UWF retinal mosaic.
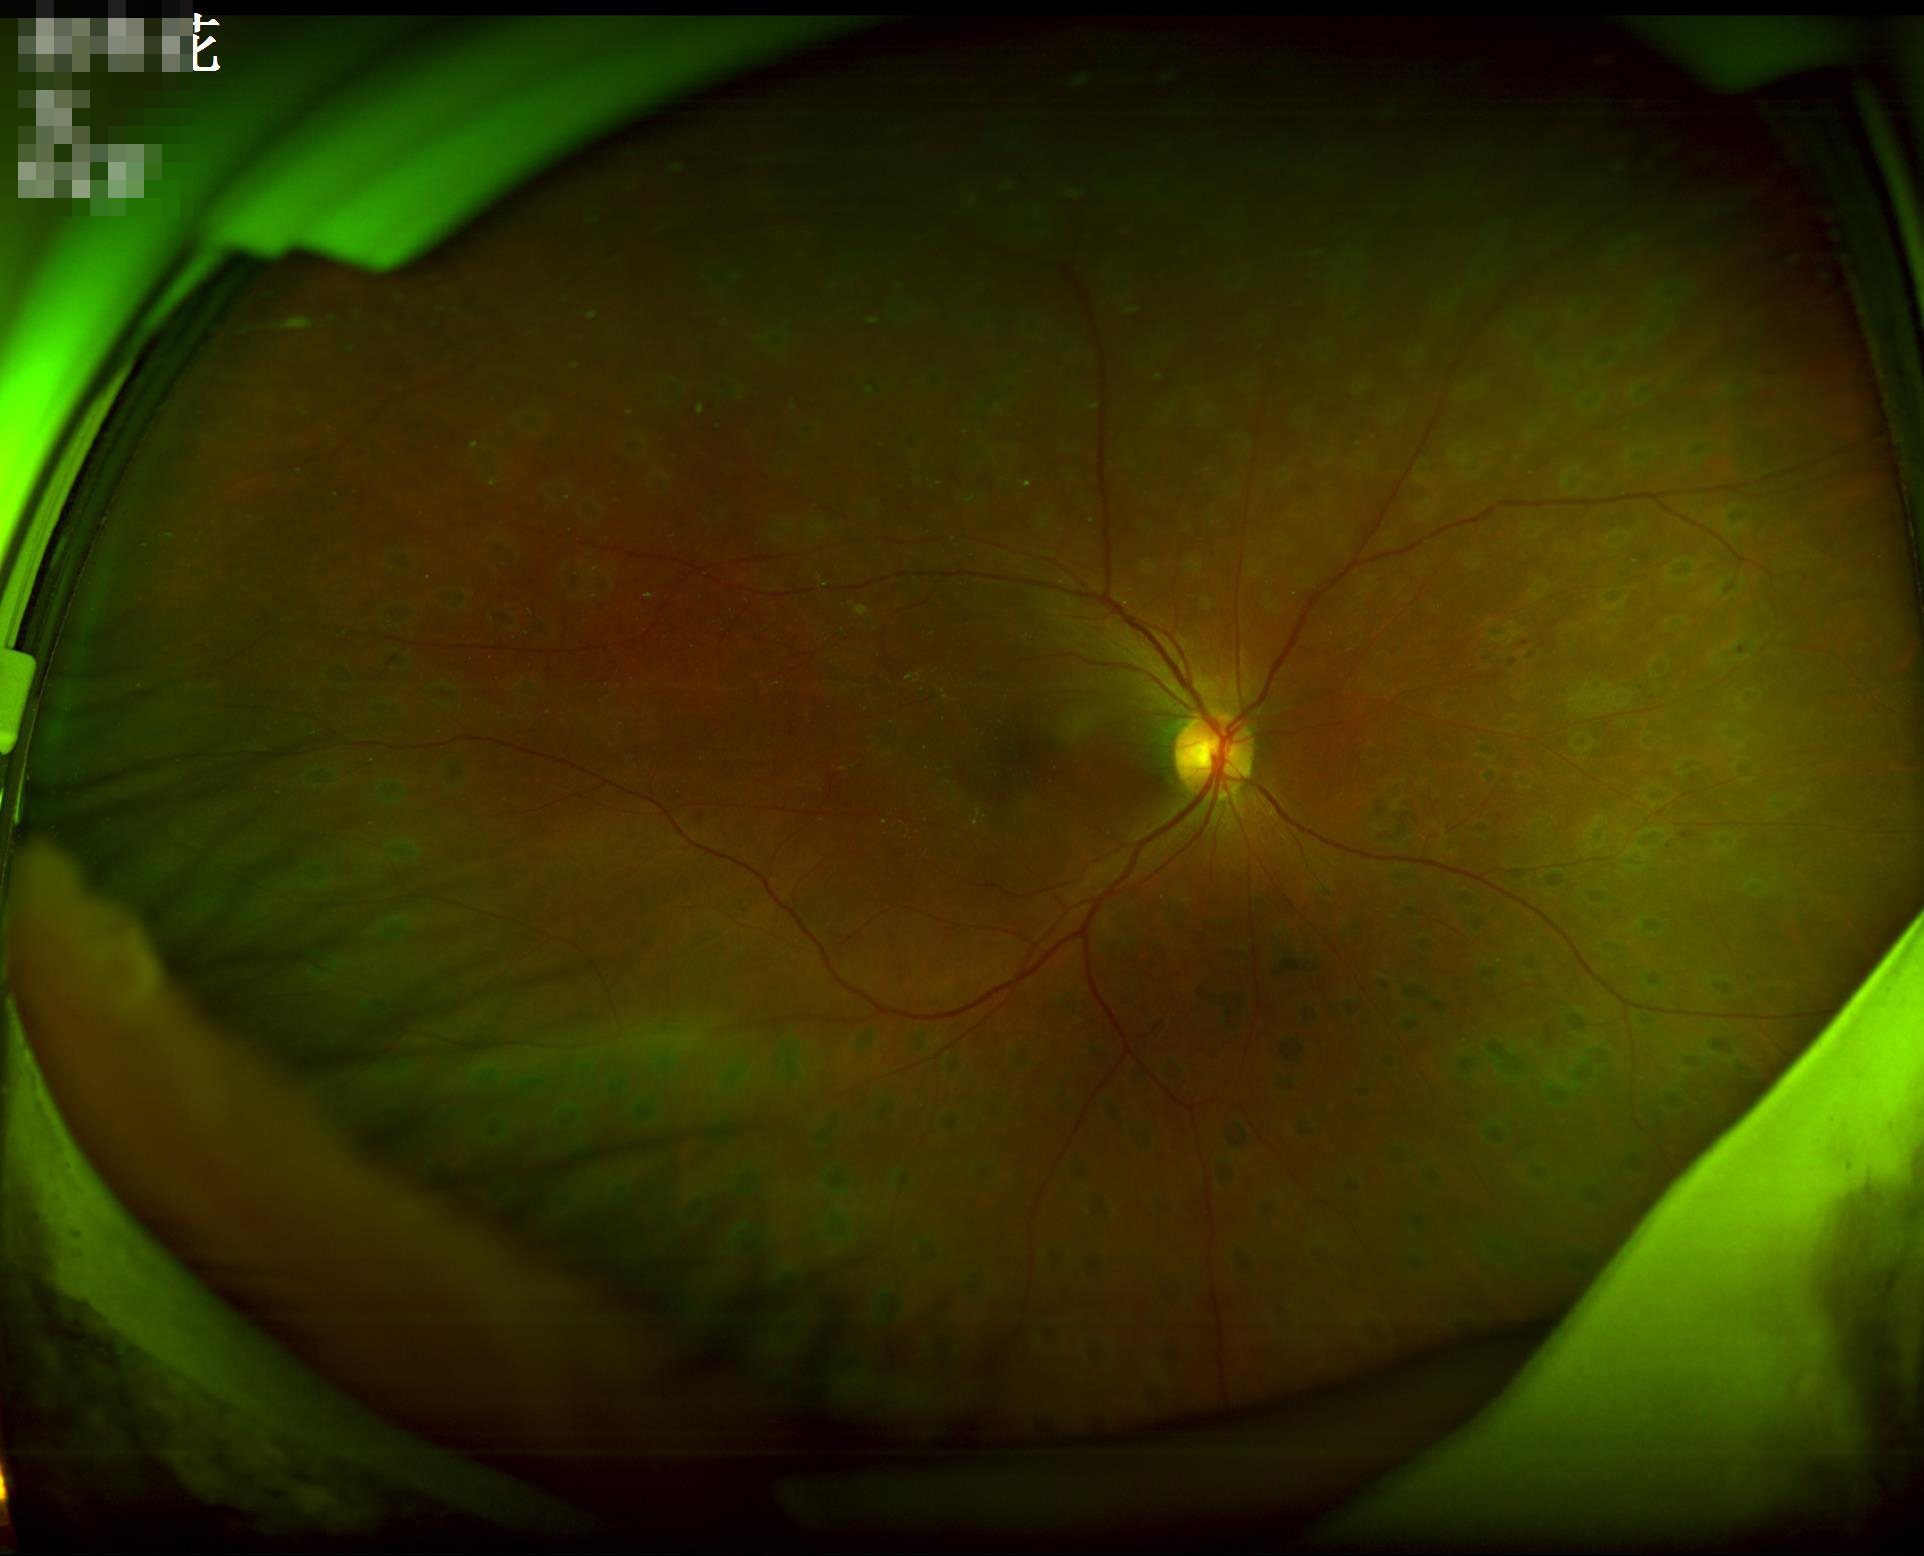 Good dynamic range. The image is clear. Acceptable image quality. Illumination and color balance are good.